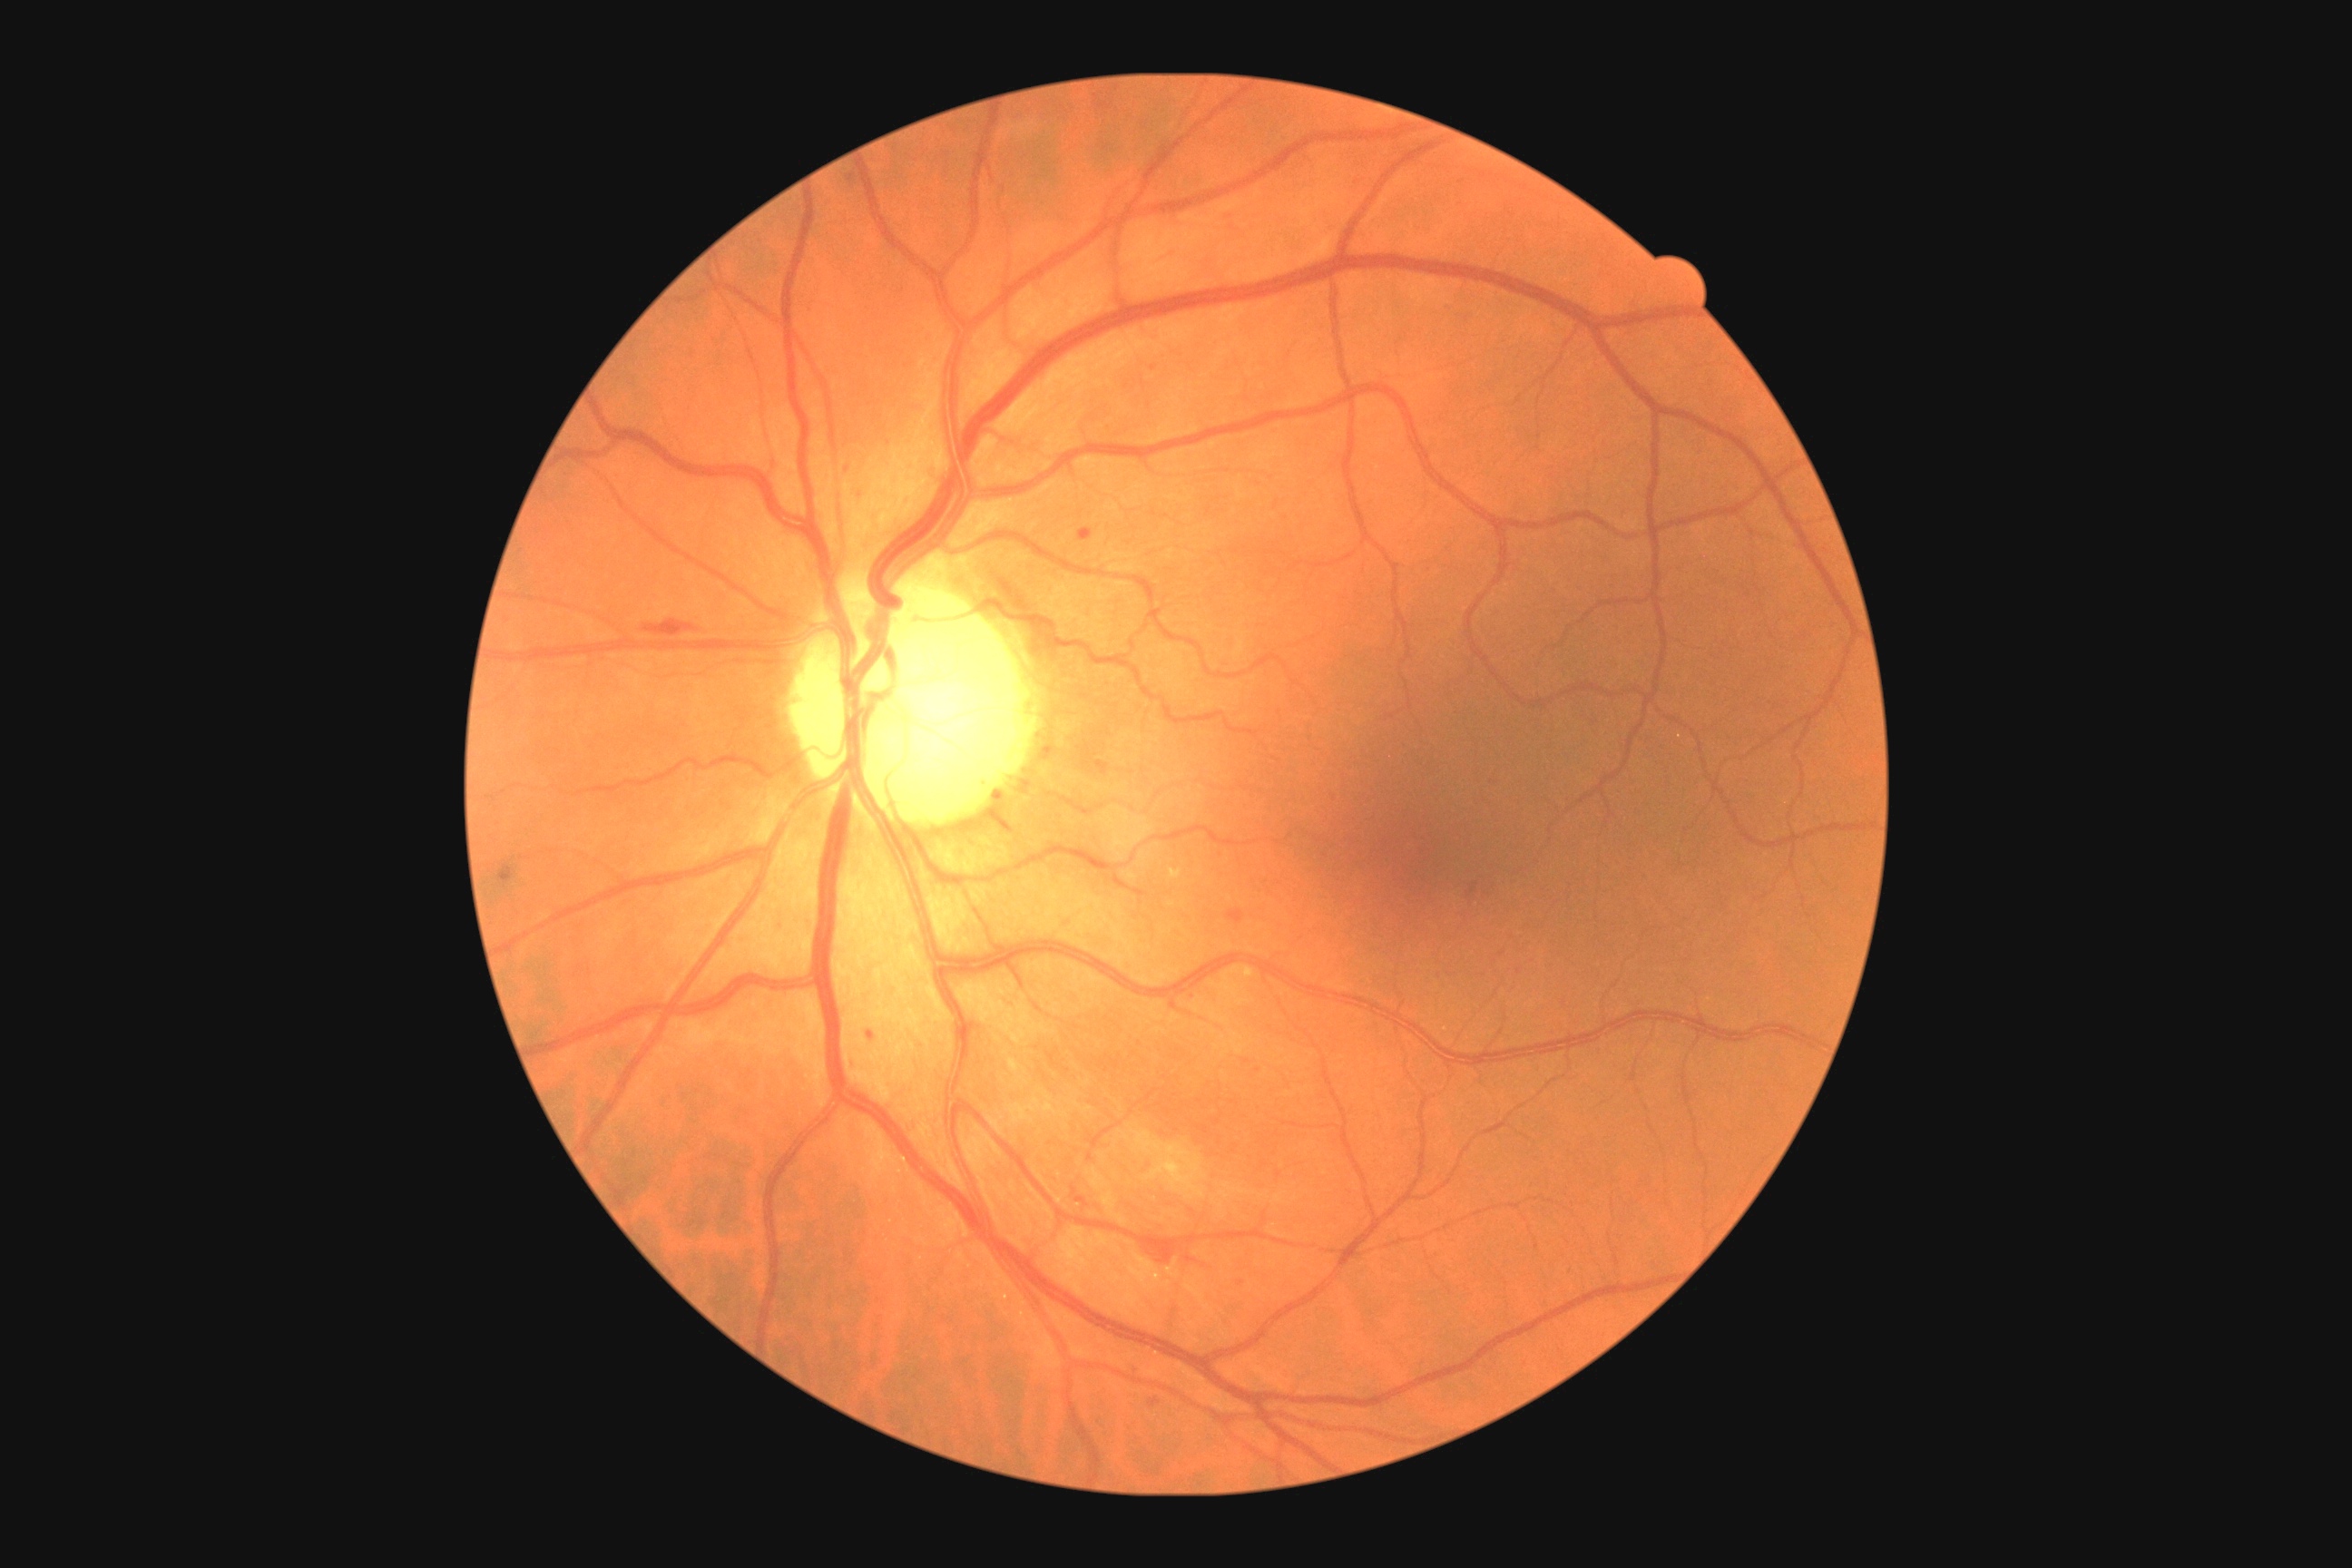

Diabetic retinopathy (DR): grade 2 (moderate NPDR); non-proliferative diabetic retinopathy. Hemorrhages (HEs) found at 643/611/692/634; 1144/1246/1177/1264; 1184/1257/1199/1264; 1226/910/1244/925. Hard exudates (EXs) found at 1170/870/1182/879; 1231/966/1255/979; 1010/1059/1023/1073. Microaneurysms (MAs) (partial list) at 1467/890/1475/896; 1150/1398/1161/1407; 995/789/1006/812; 1079/527/1093/542; 848/1057/856/1070; 1132/1366/1139/1377; 868/1032/876/1041; 1493/781/1500/792; 843/467/850/475. MAs (small, approximate centers) near {"x": 1241, "y": 1283}; {"x": 862, "y": 497}; {"x": 1258, "y": 1071}; {"x": 1476, "y": 885}; {"x": 1153, "y": 369}; {"x": 781, "y": 931}. No soft exudates (SEs) identified.